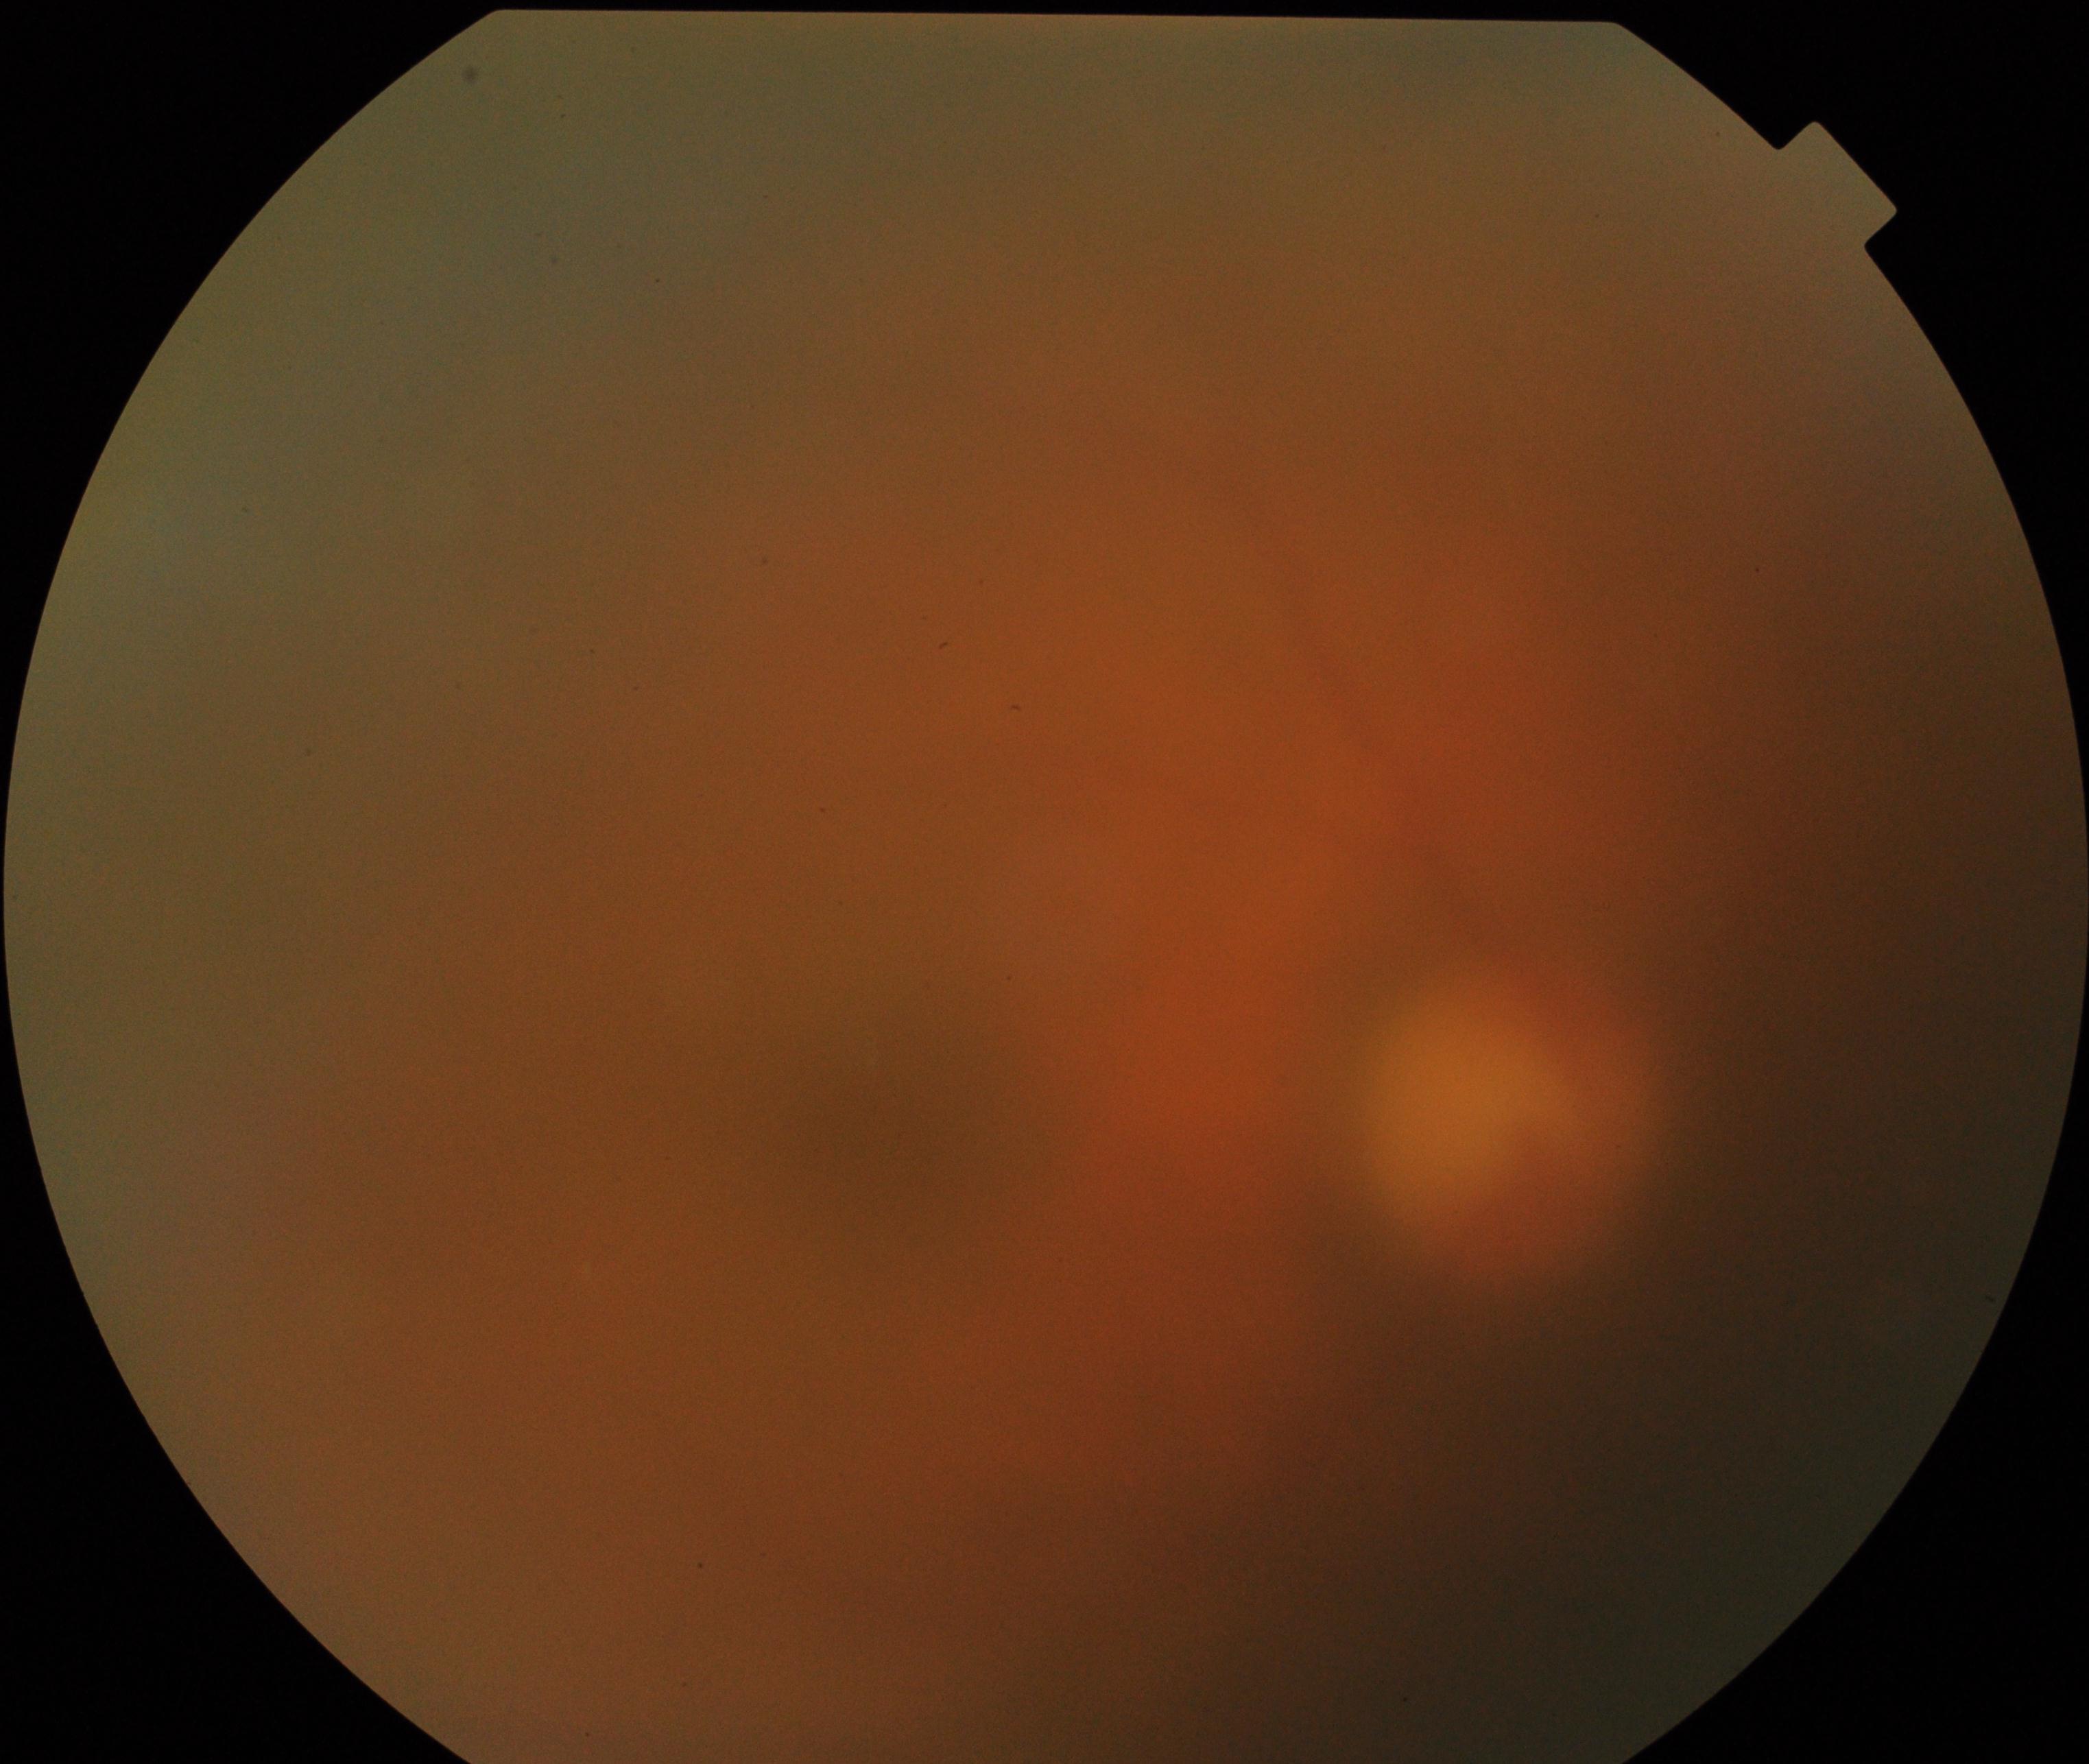

Image quality: significantly degraded.
Proliferative diabetic retinopathy: negative.